CFP; NIDEK AFC-230; graded on the modified Davis scale
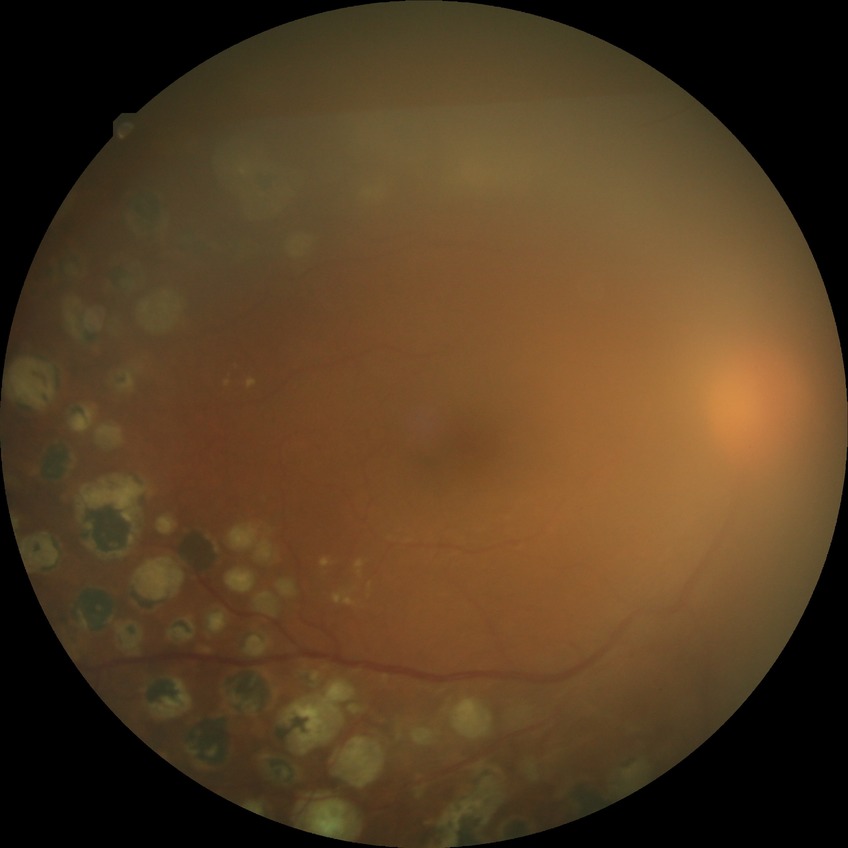 Assessment:
• Davis stage: PDR